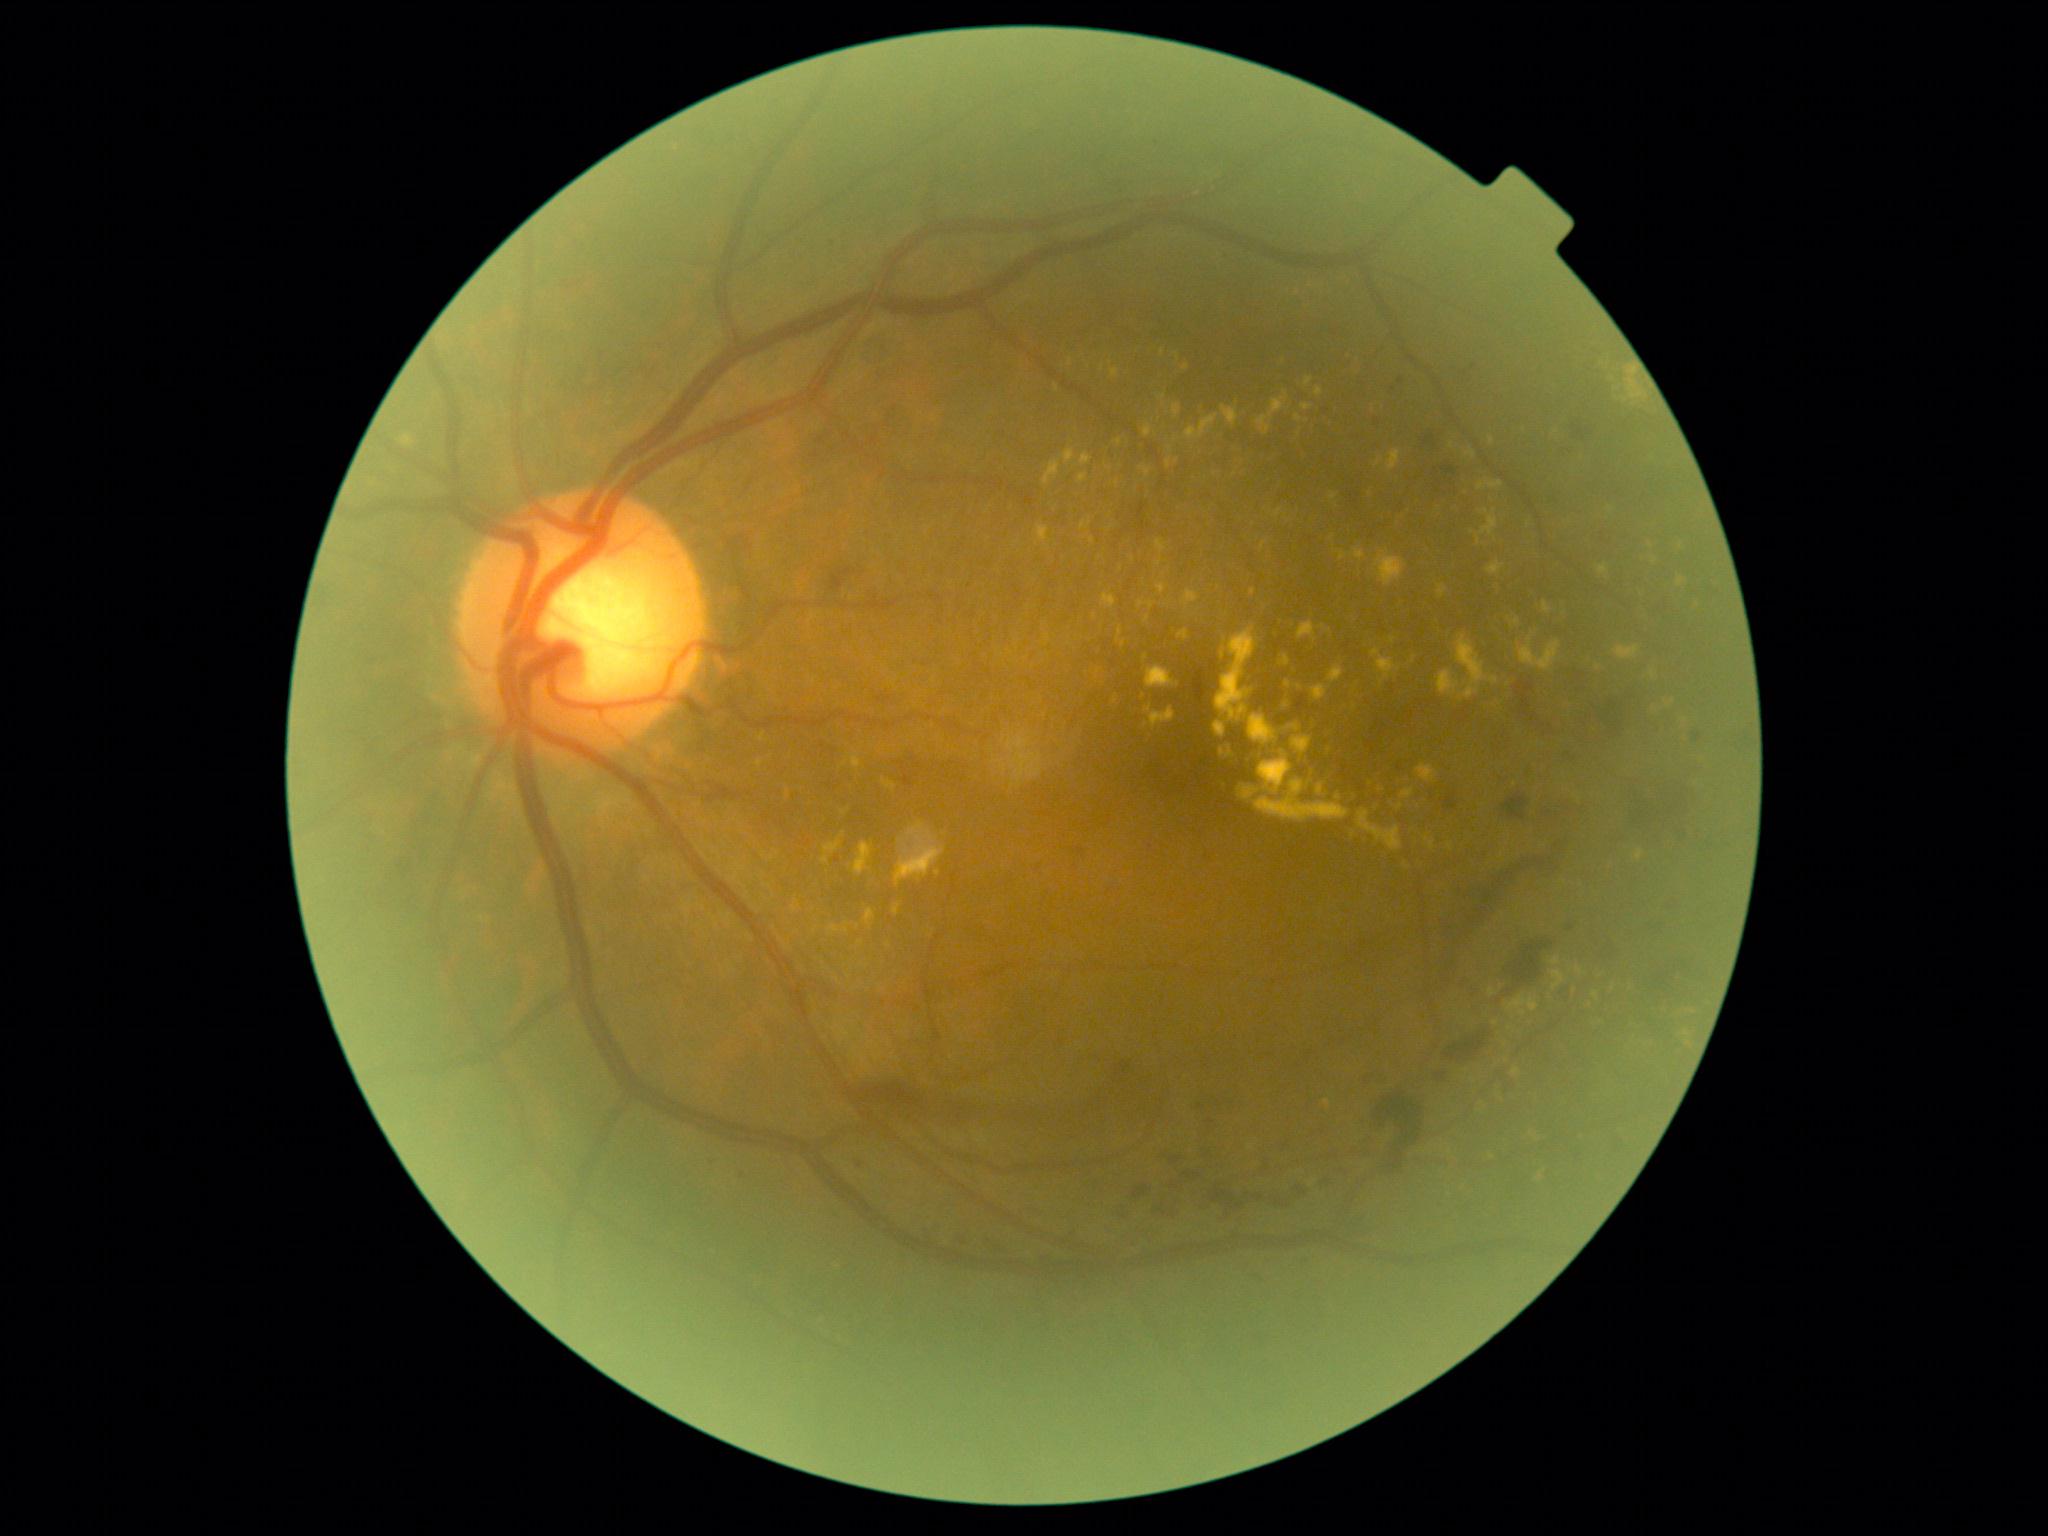

Diabetic retinopathy (DR) is 2
Selected lesions:
hard exudates (EXs) (subset): Rect(1221, 647, 1227, 659), Rect(1456, 636, 1488, 699), Rect(1117, 627, 1123, 643), Rect(1315, 387, 1323, 398), Rect(1552, 971, 1565, 991), Rect(1490, 988, 1497, 997), Rect(853, 754, 861, 769), Rect(1146, 666, 1178, 689), Rect(1064, 450, 1075, 464), Rect(1293, 737, 1313, 756)
Additional small EXs near <pt>1611,509</pt>, <pt>1333,538</pt>, <pt>1162,397</pt>, <pt>1112,528</pt>, <pt>1115,701</pt>, <pt>1186,368</pt>, <pt>1253,592</pt>, <pt>1494,681</pt>, <pt>1121,569</pt>